Ultra-widefield fundus photograph, 200° field of view: 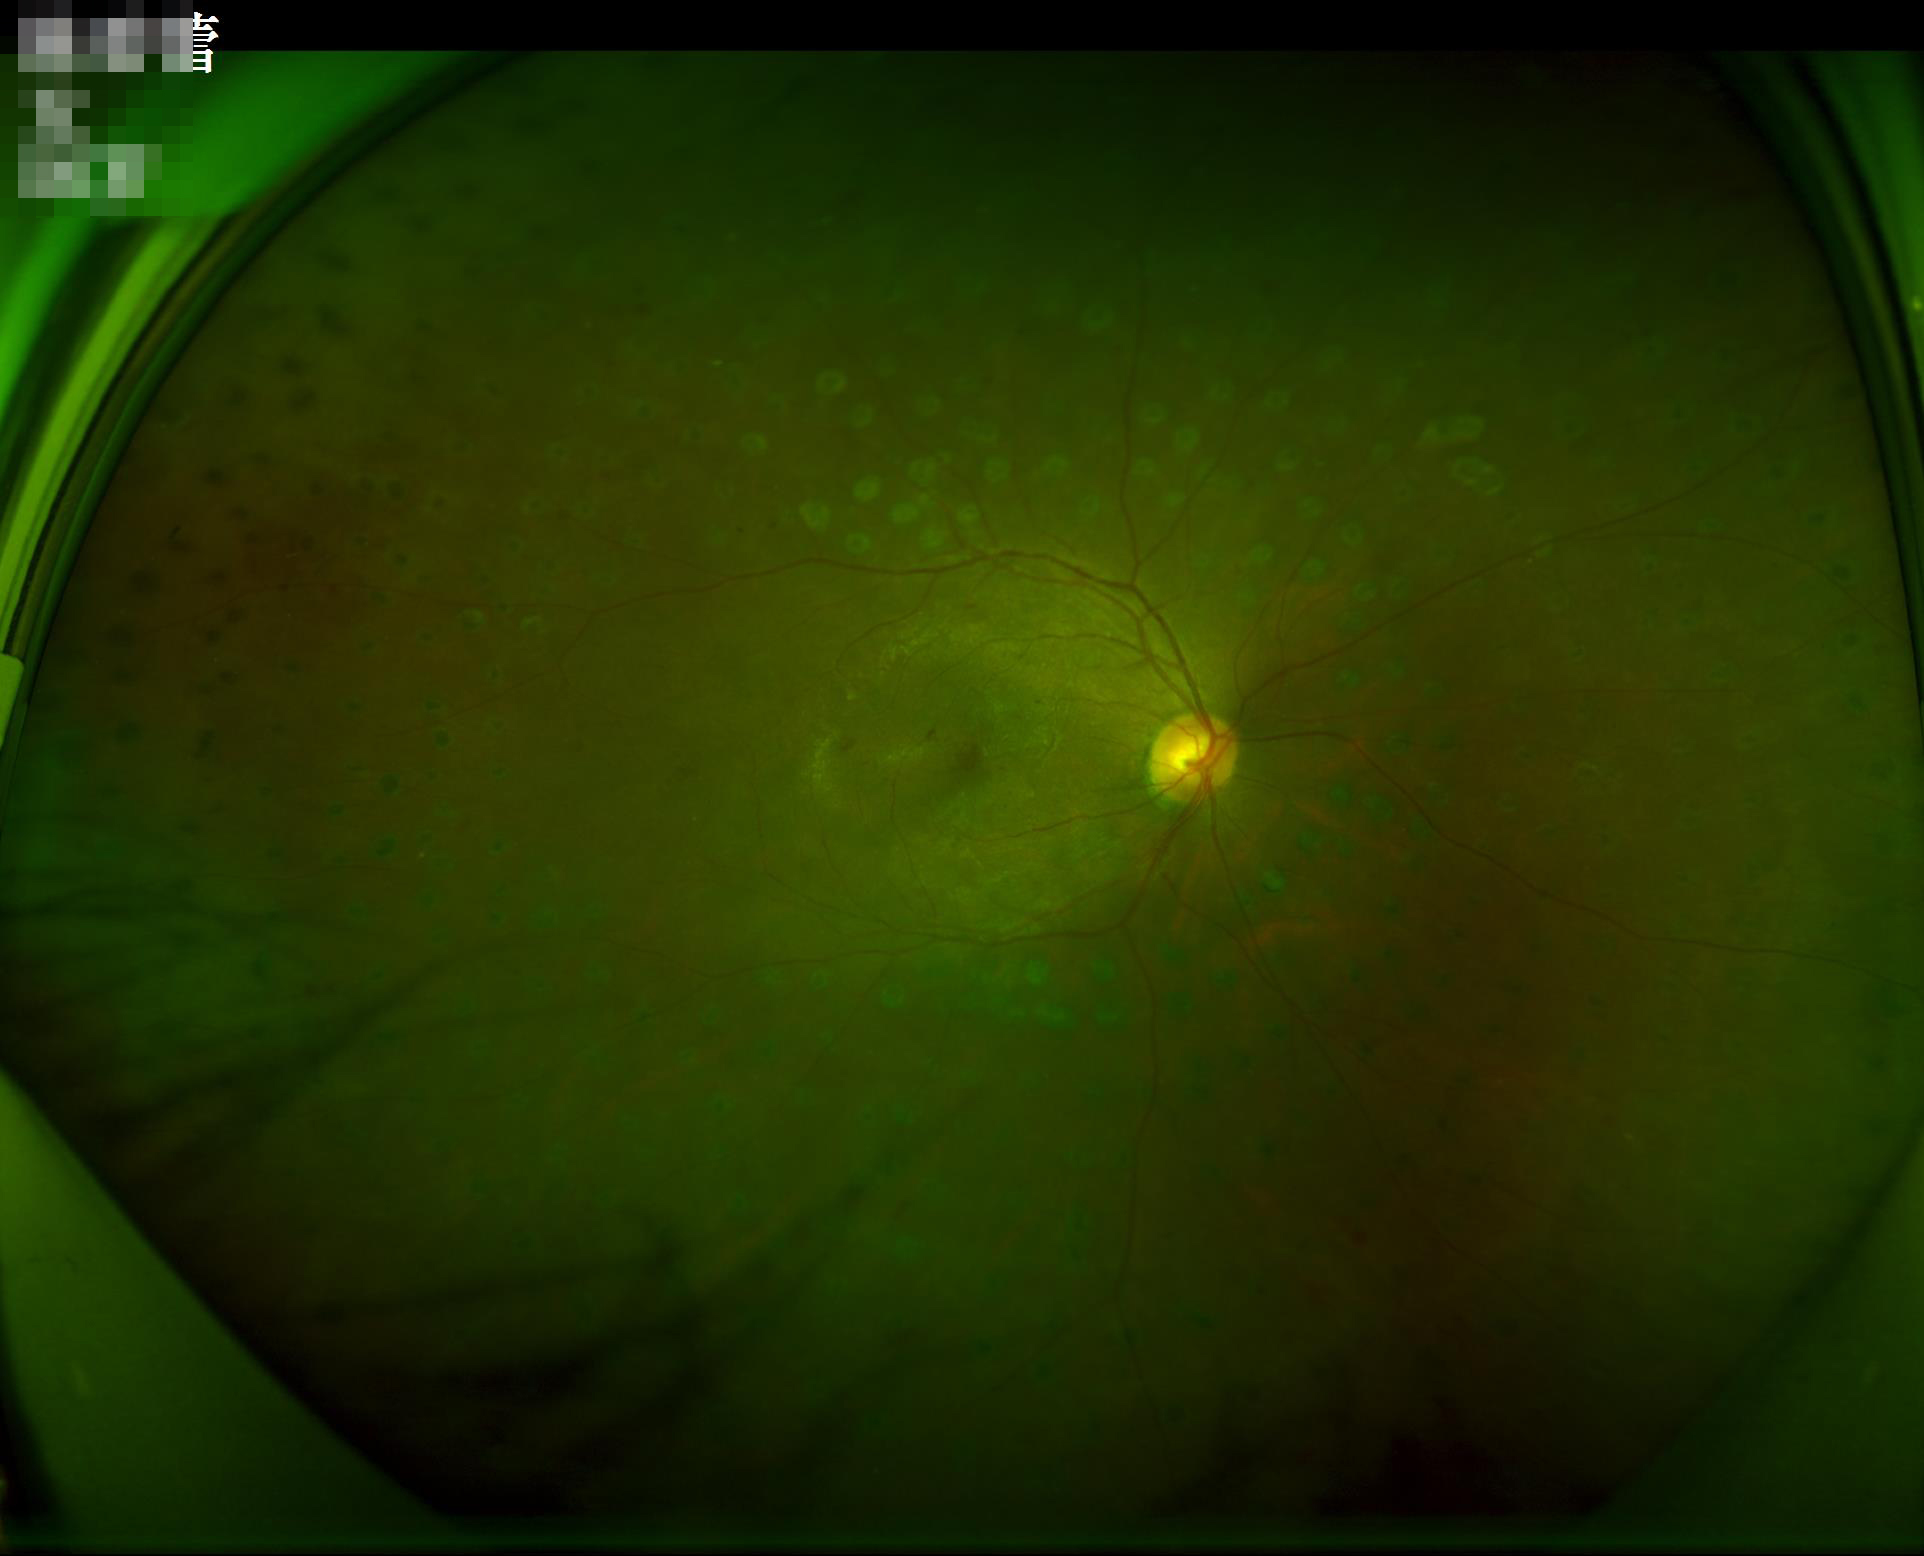 illumination: even
overall_quality: acceptable
clarity: clear
contrast: adequate